130° field of view (Clarity RetCam 3). 640 x 480 pixels. Wide-field fundus photograph of an infant
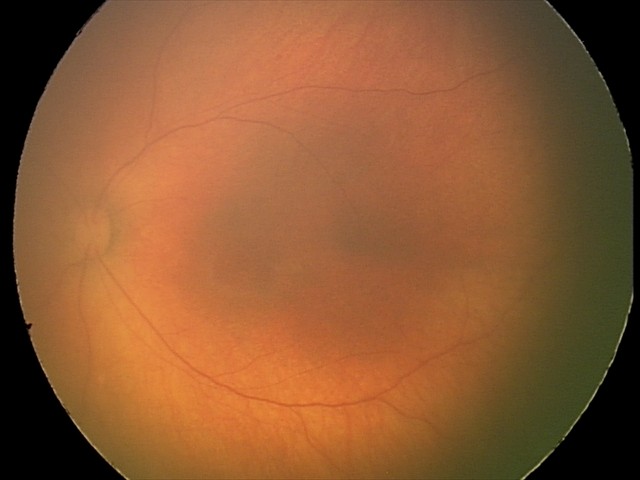 Q: What is the screening diagnosis?
A: physiological retinal finding